45° FOV. 412x310. Retinal fundus photograph — 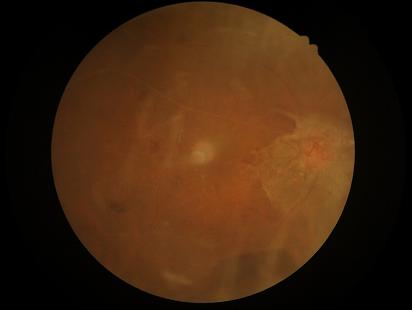

{
  "illumination": "uneven",
  "clarity": "out of focus",
  "contrast": "low",
  "overall_quality": "suboptimal"
}